Color fundus image:
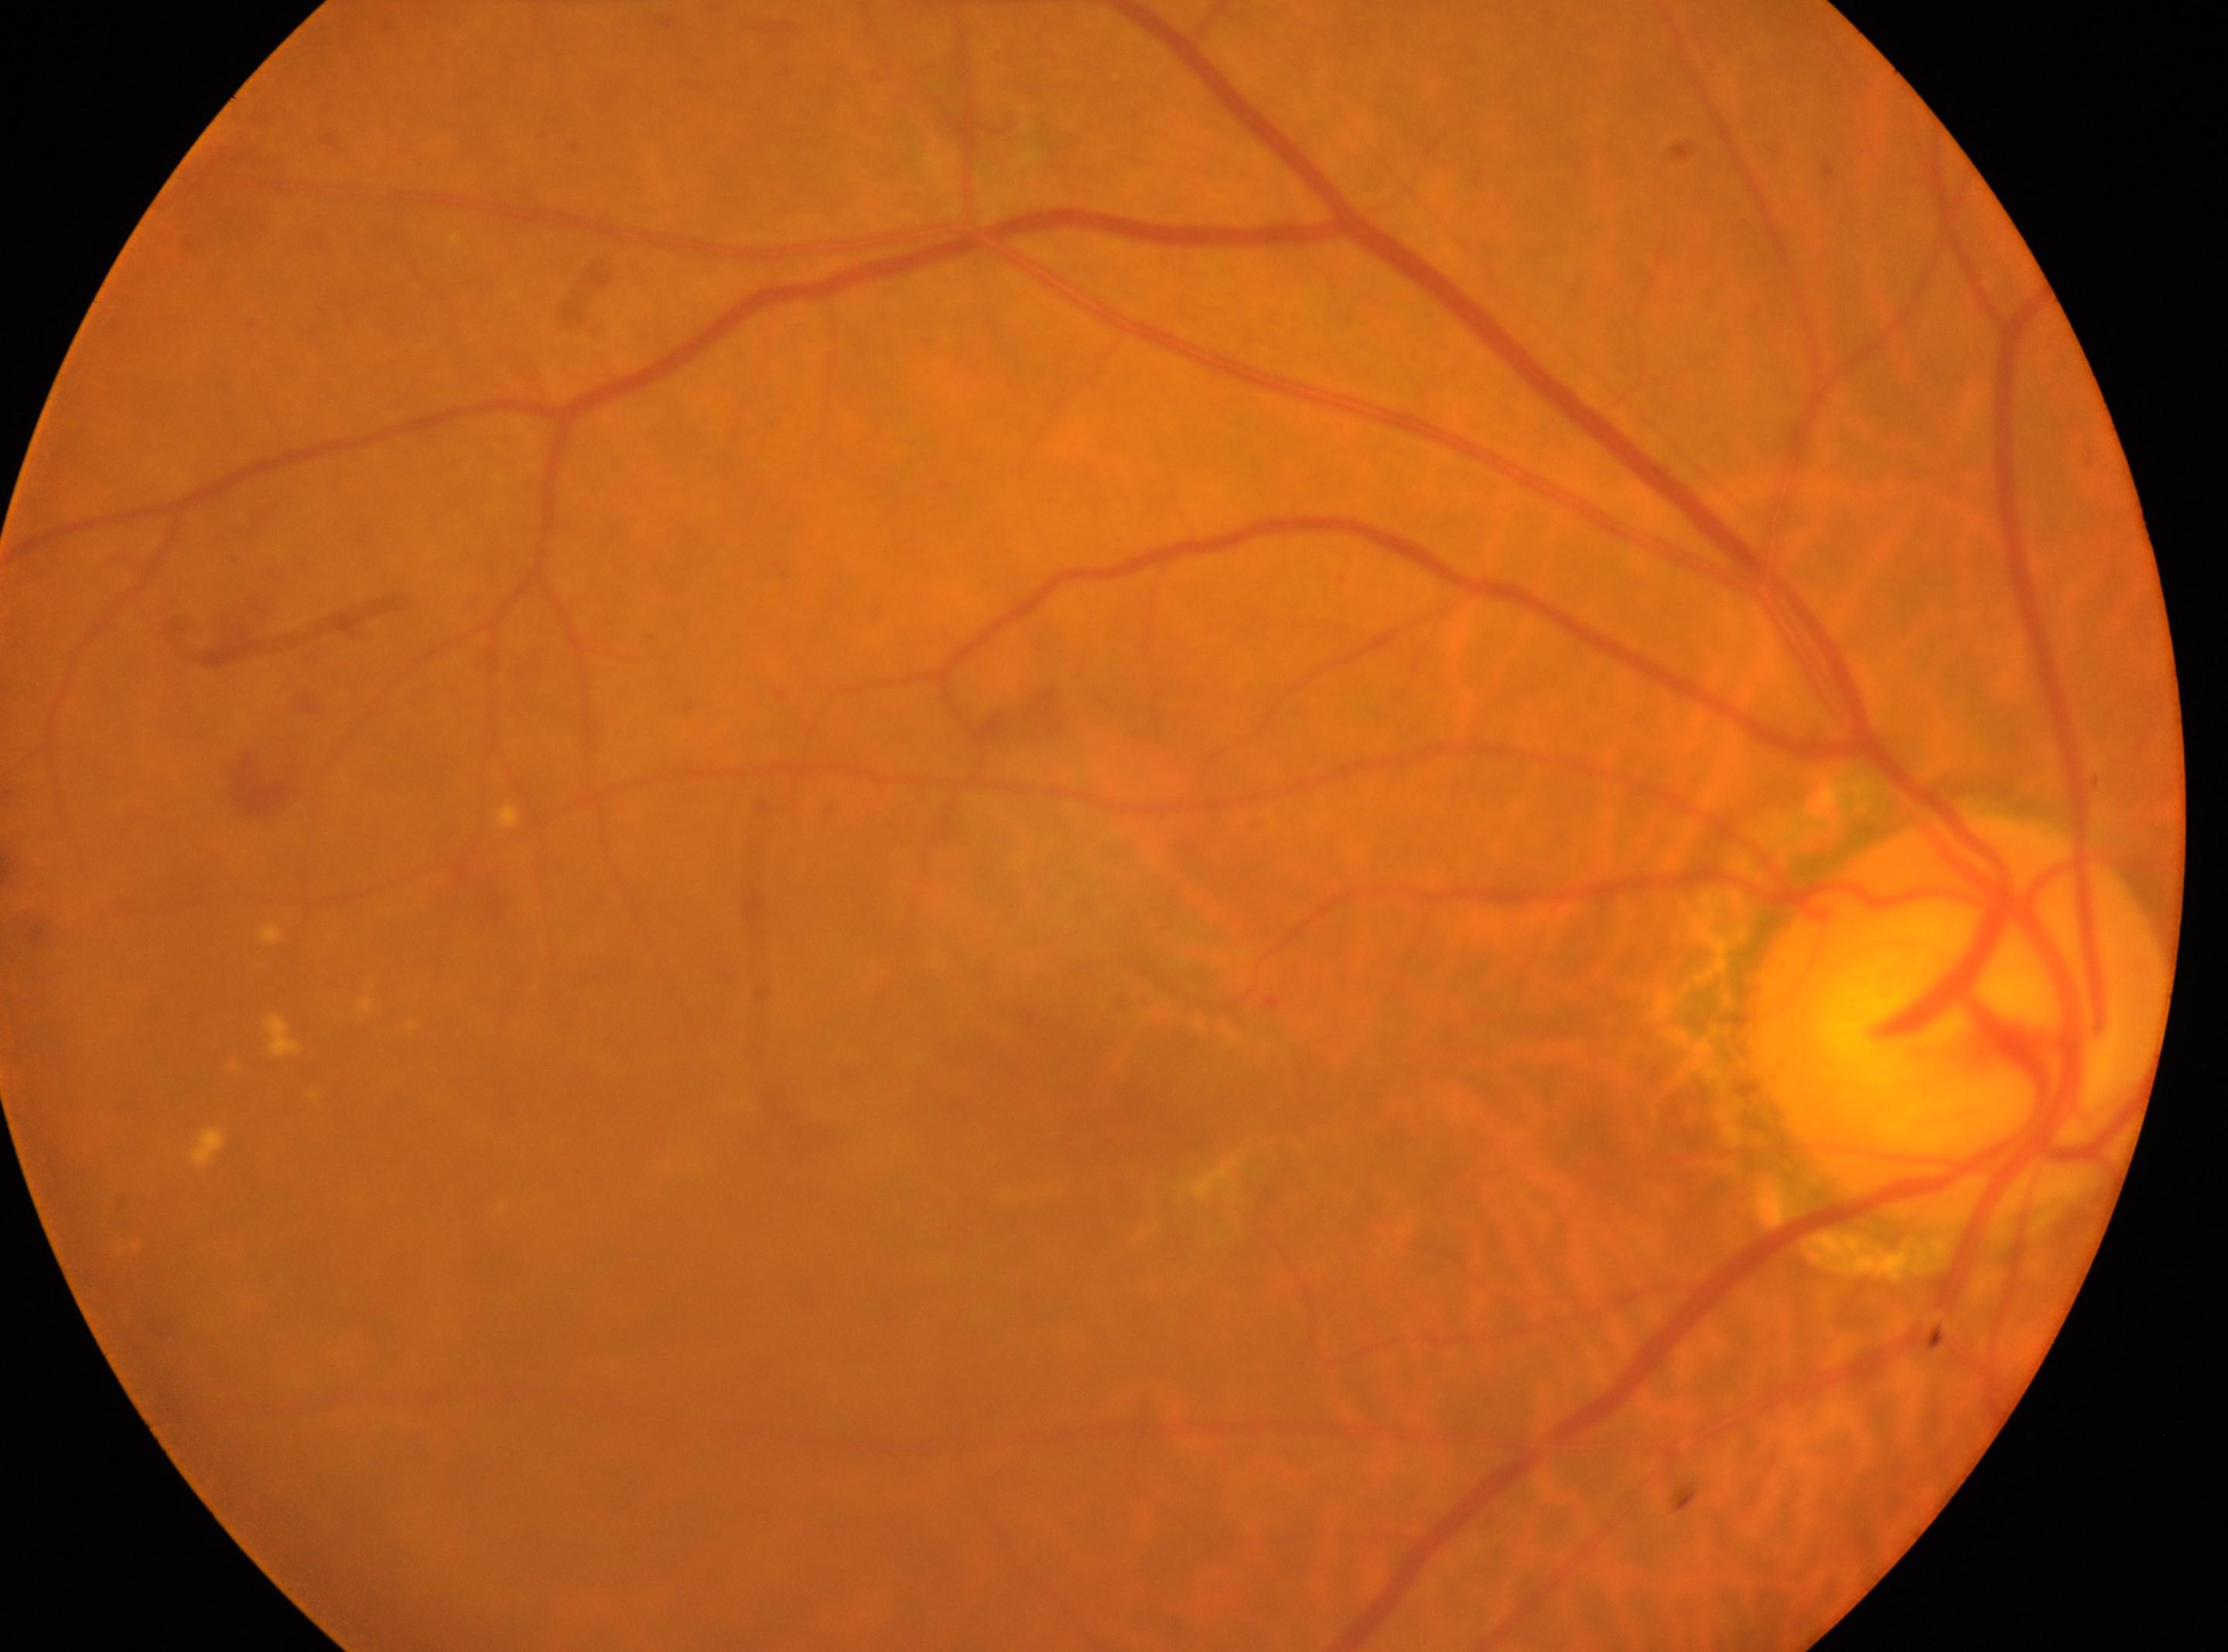

Fovea center: (1082,1109). Diabetic retinopathy (DR) is grade 2 (moderate NPDR). Optic disc located at (1959,1016). This is the oculus dexter.